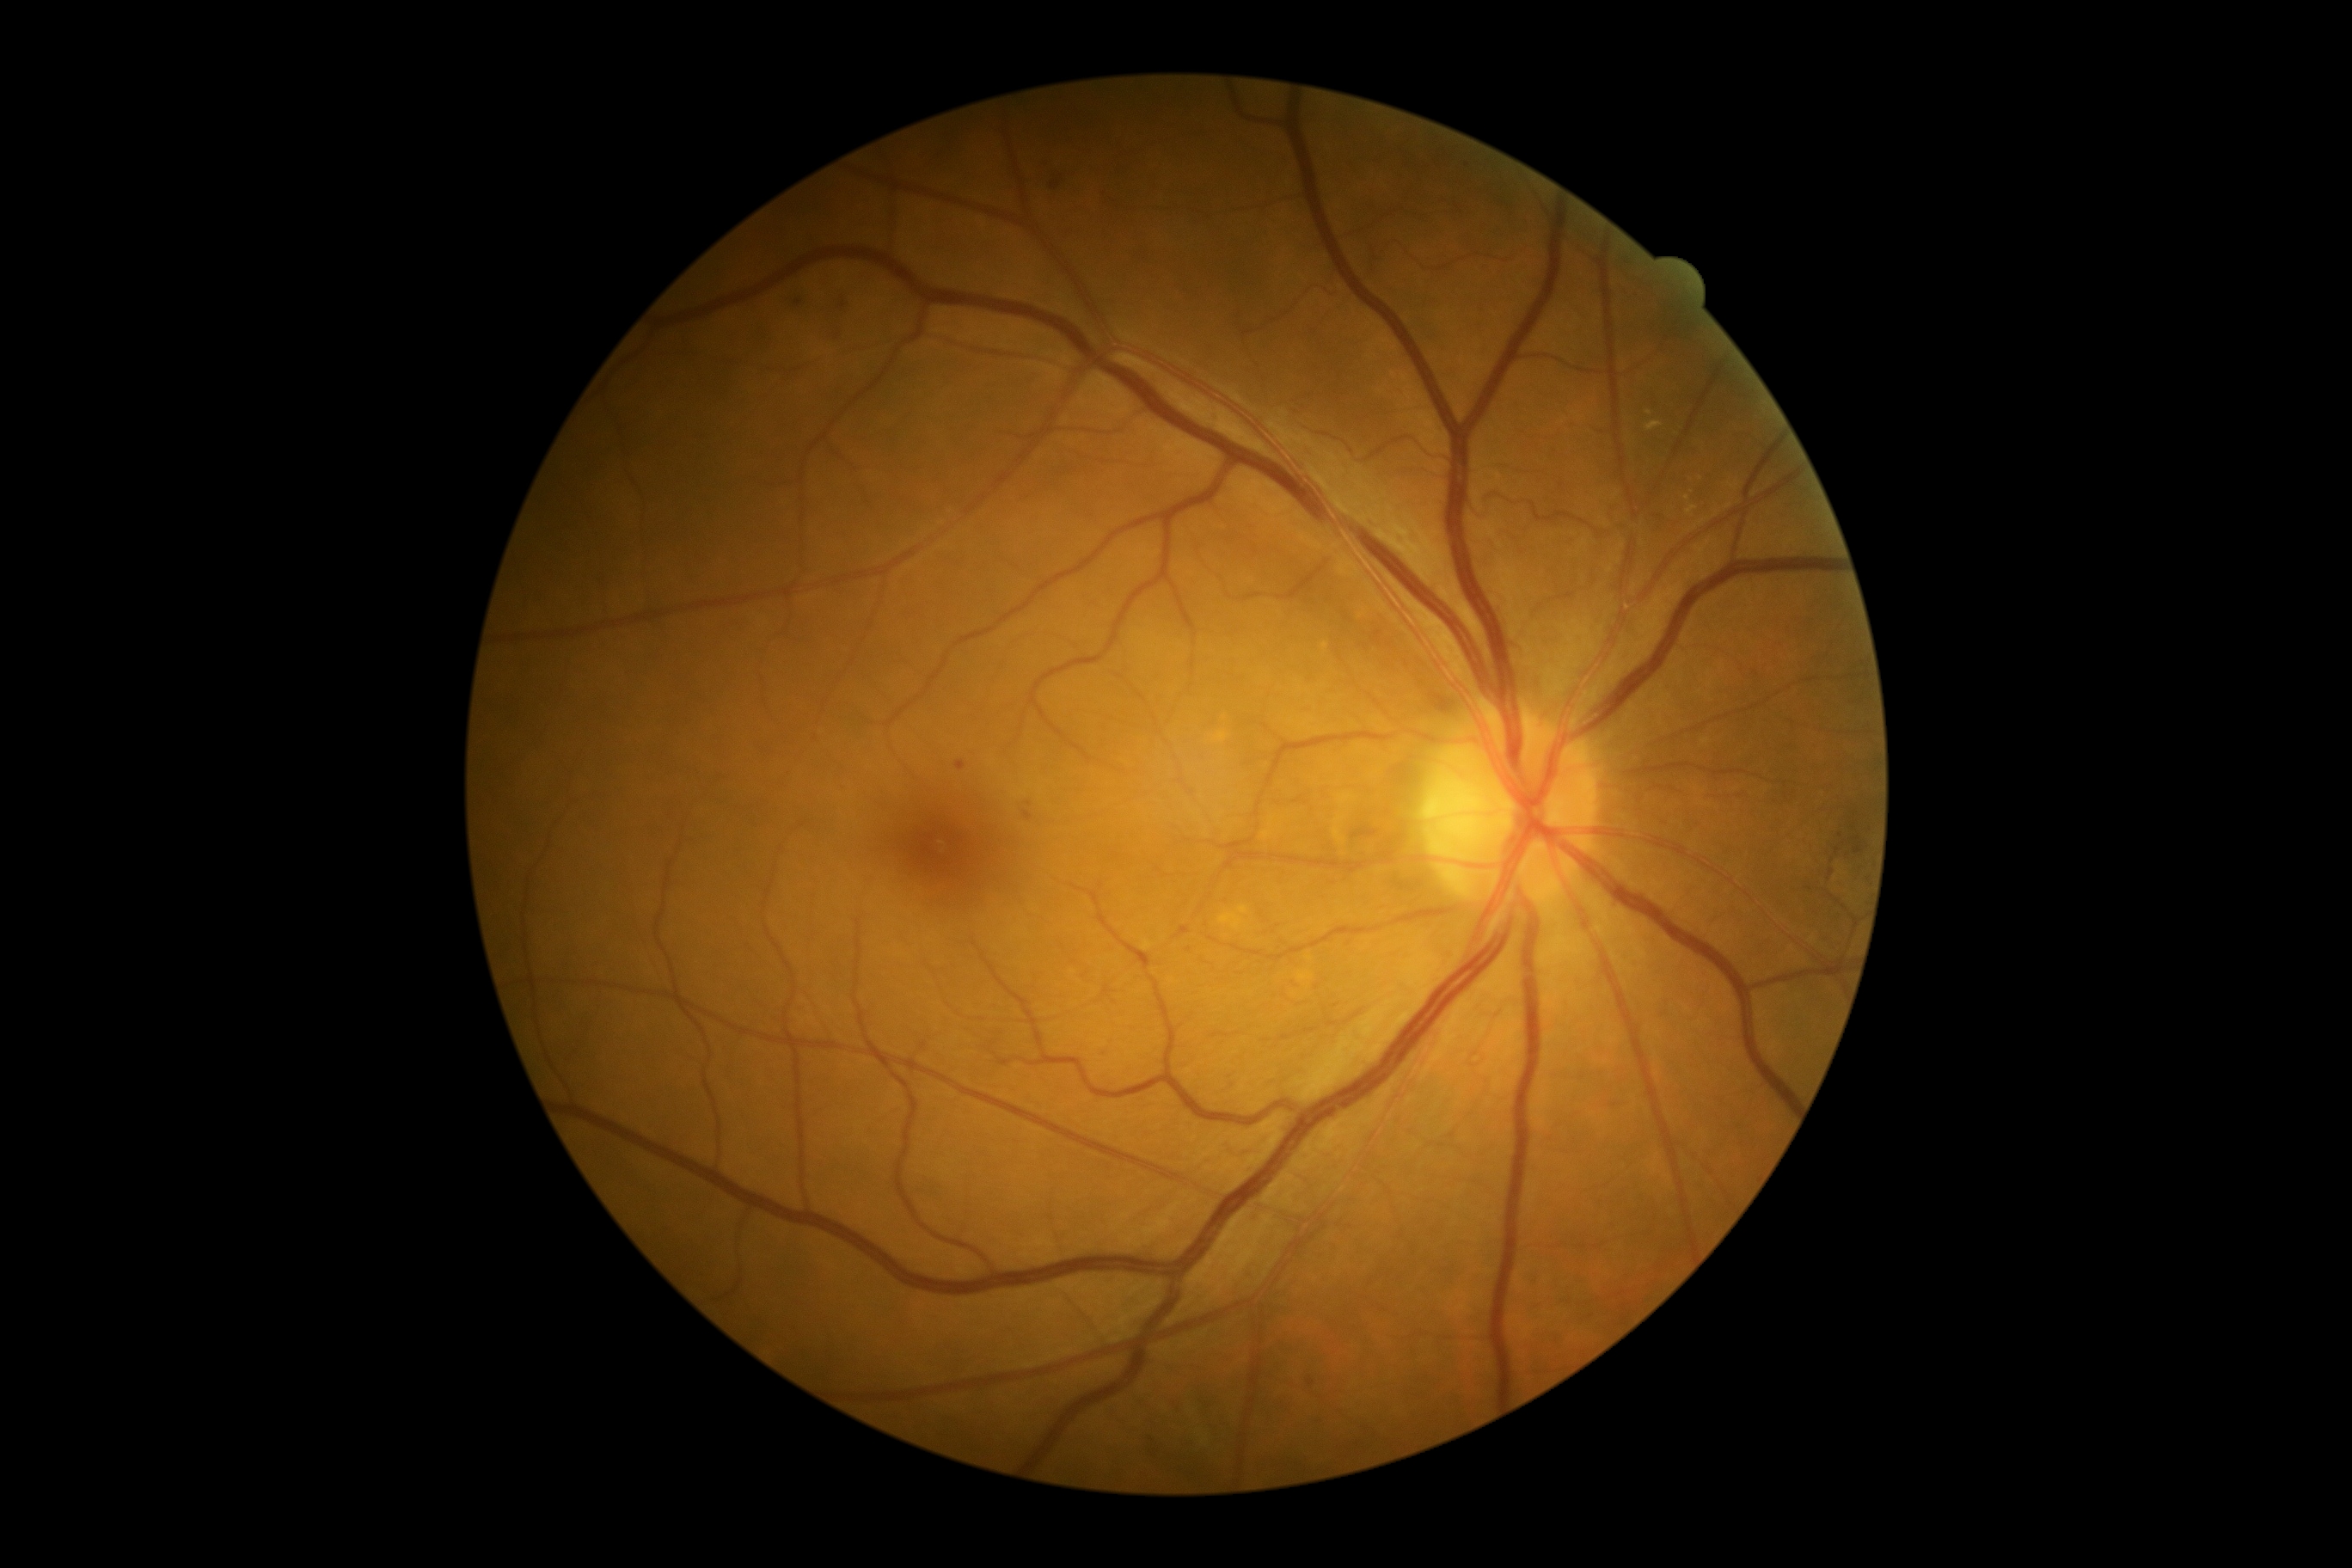
diabetic retinopathy (DR): moderate NPDR (grade 2) — more than just microaneurysms but less than severe NPDR